Captured with the Phoenix ICON (100° field of view). Wide-field fundus photograph of an infant: 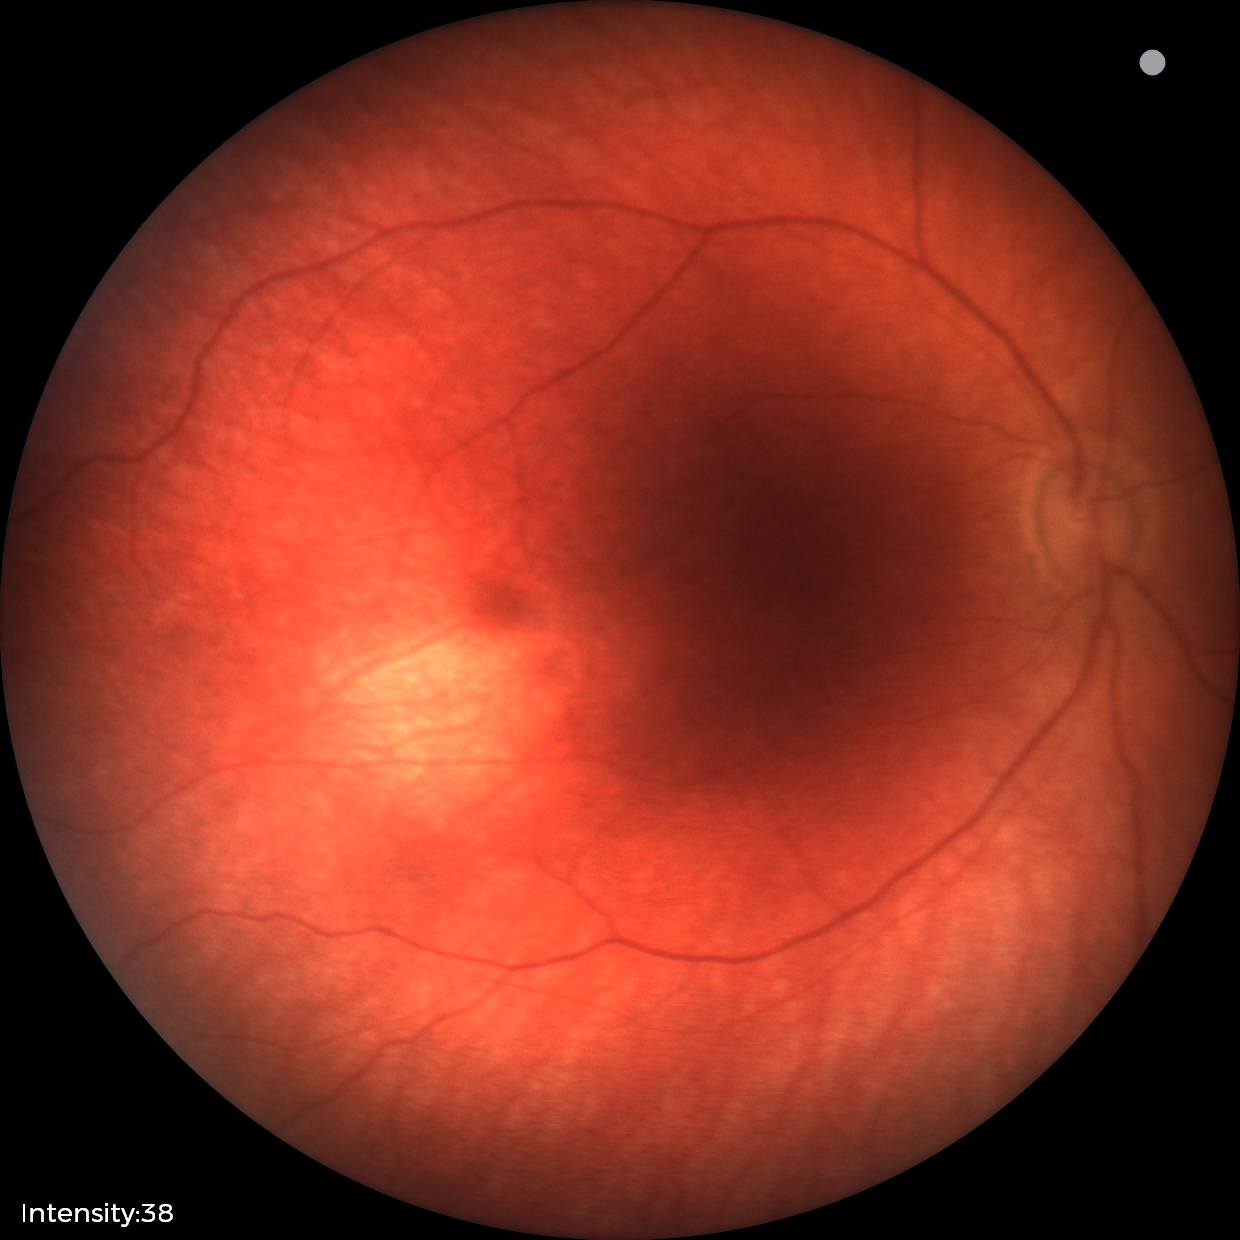

Examination with physiological retinal findings.